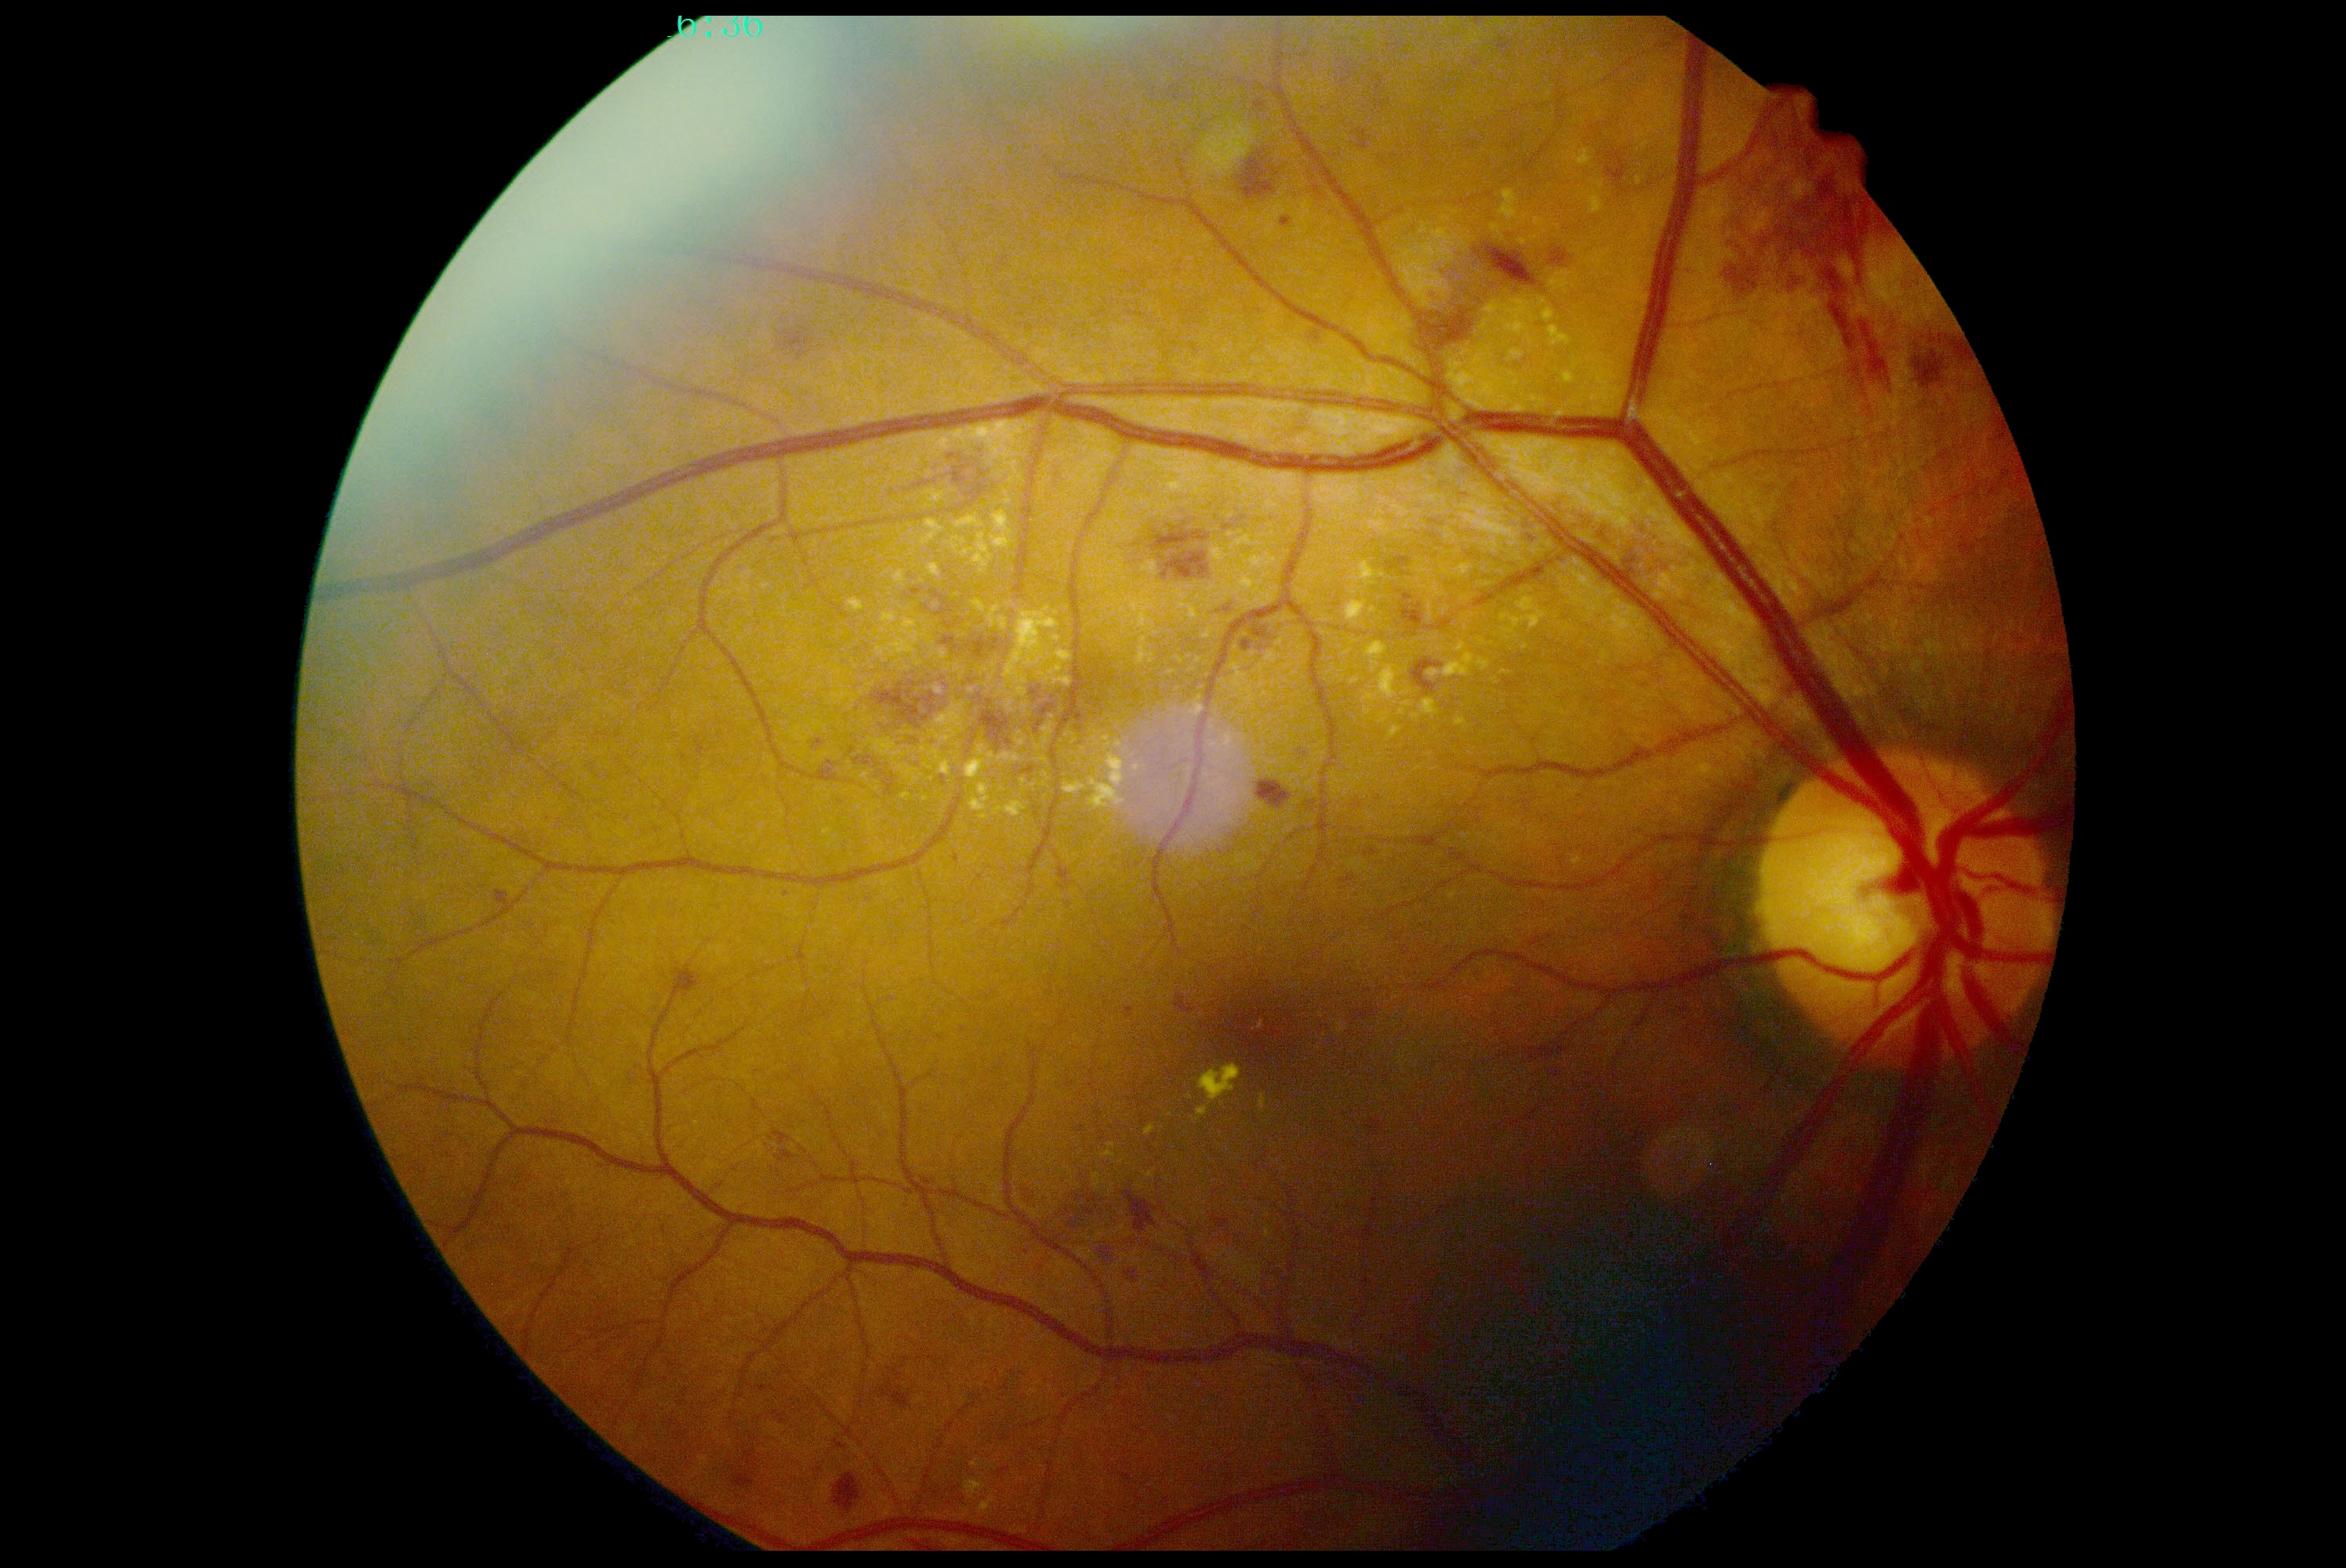
Retinopathy is grade 2 (moderate NPDR).